Retinal fundus photograph:
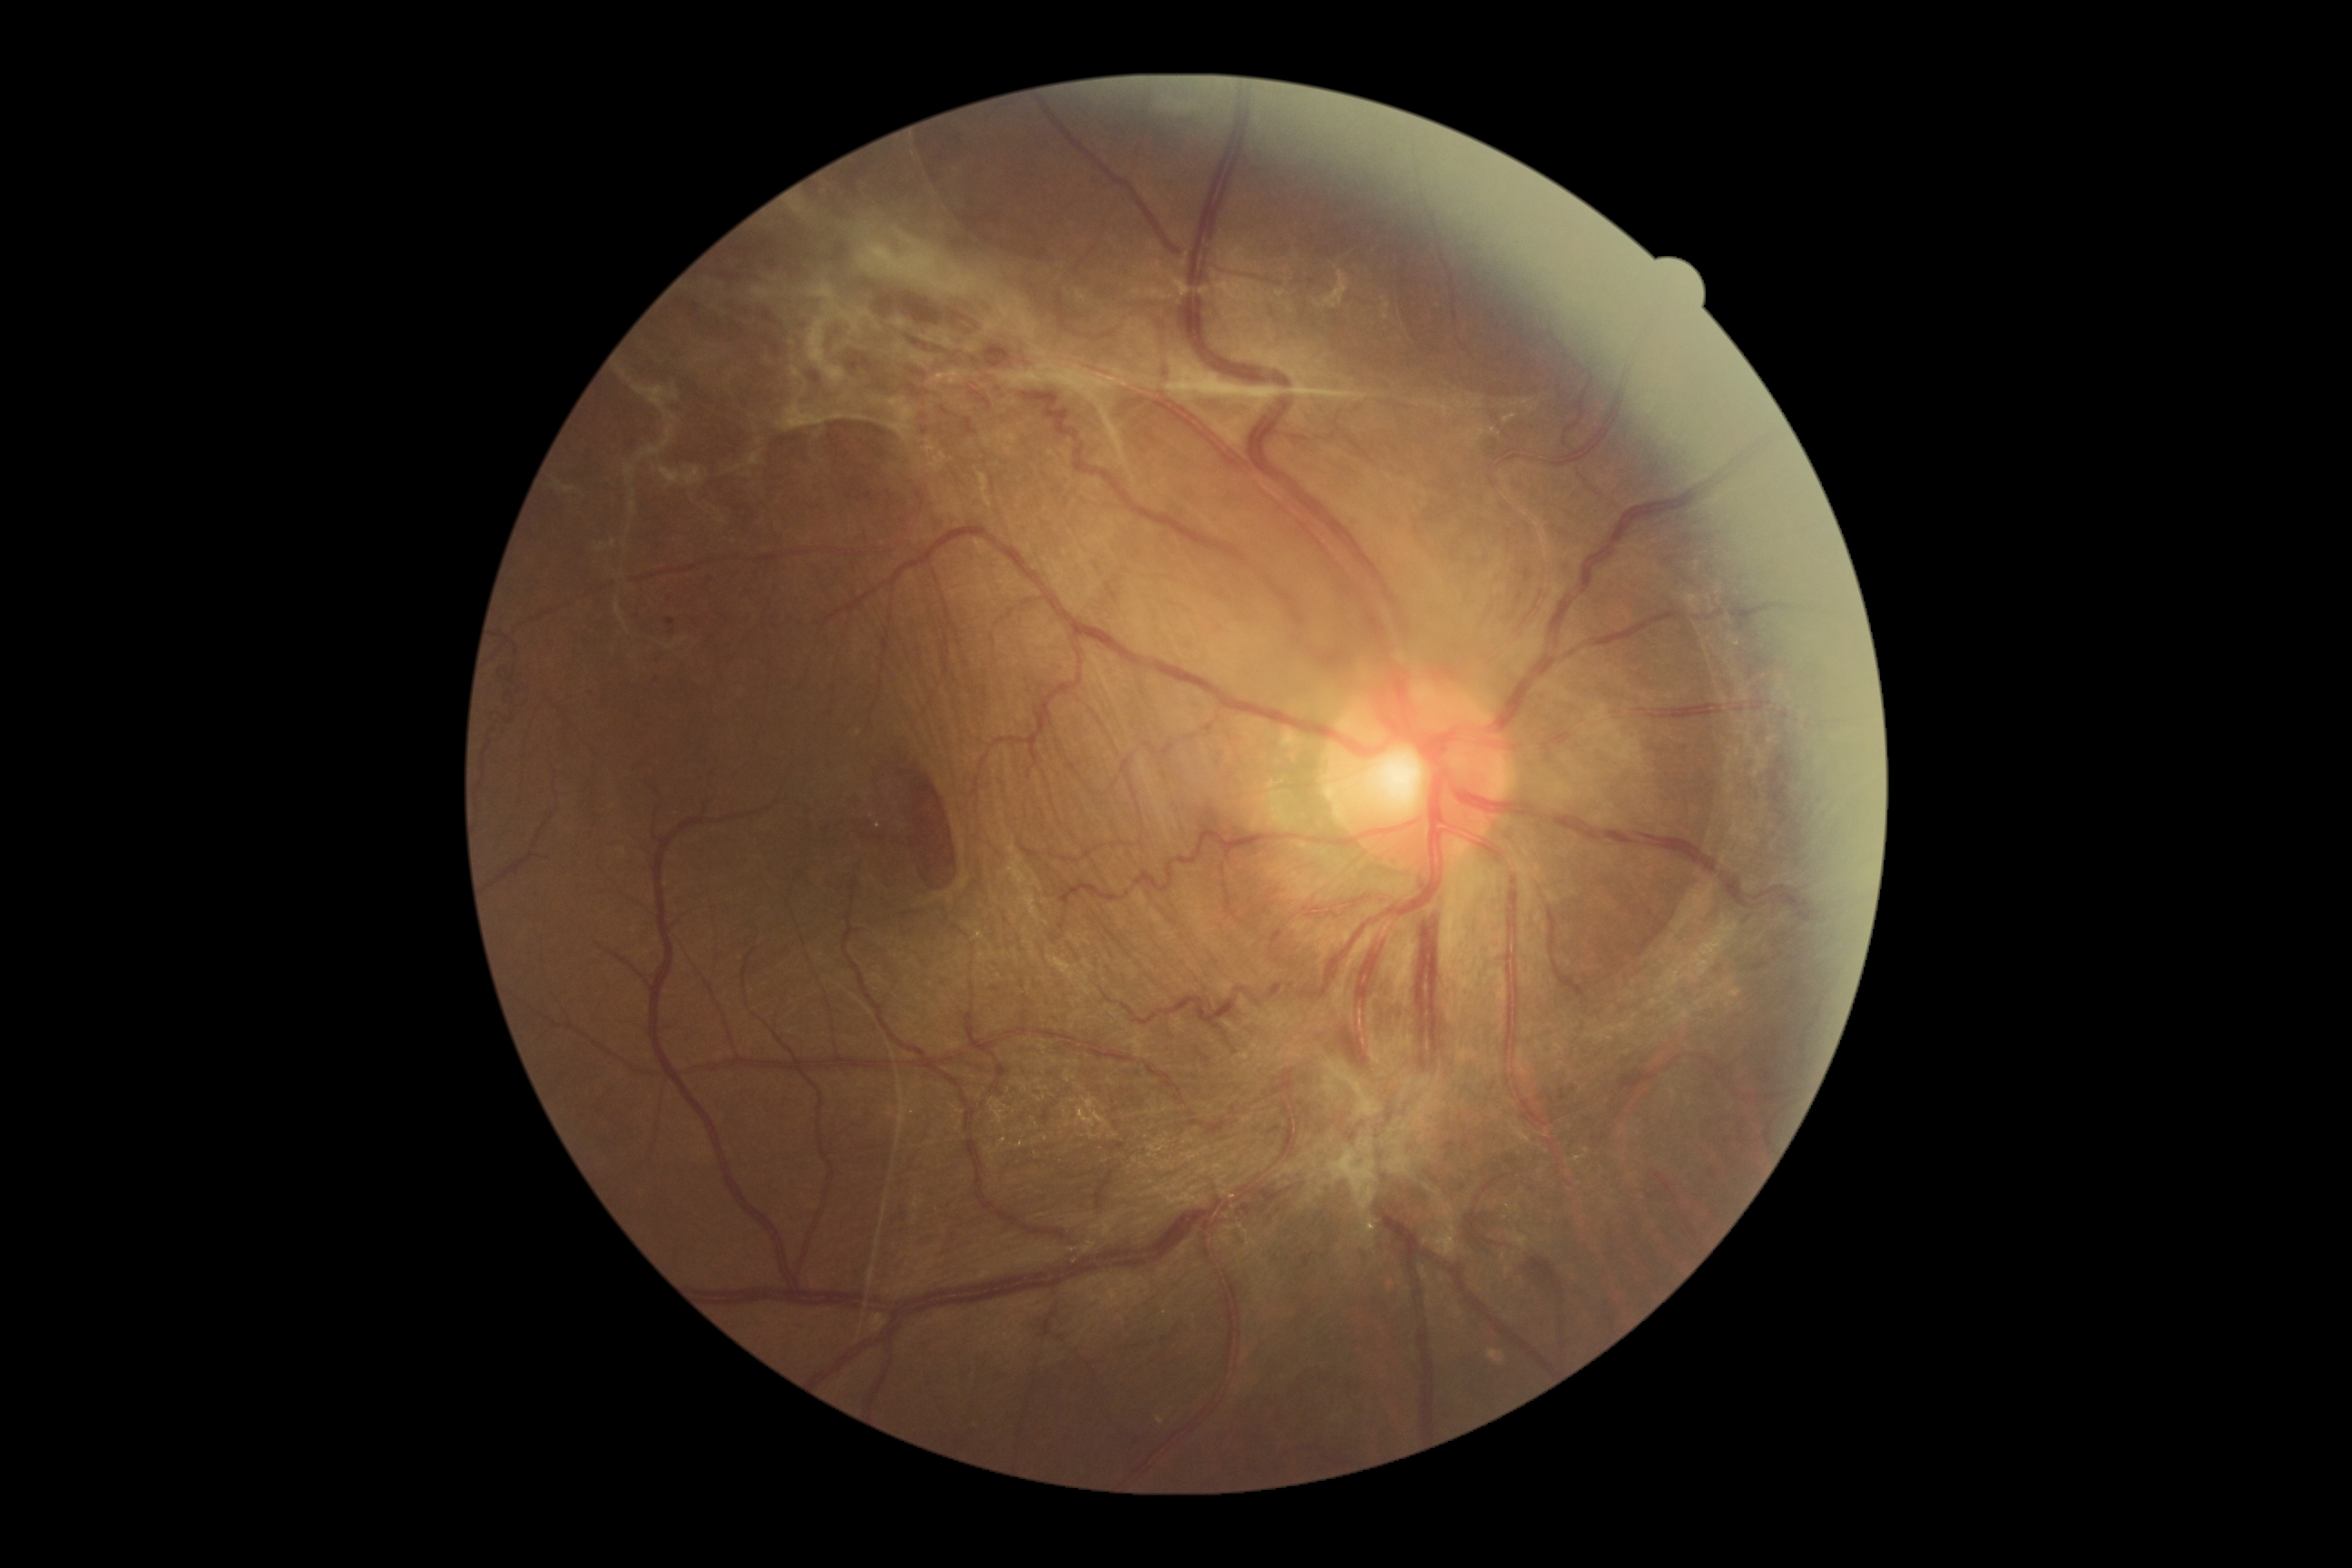 The retinopathy is classified as proliferative diabetic retinopathy. DR stage is 4/4.